Graded on the modified Davis scale · retinal fundus photograph · camera: NIDEK AFC-230 · 848x848:
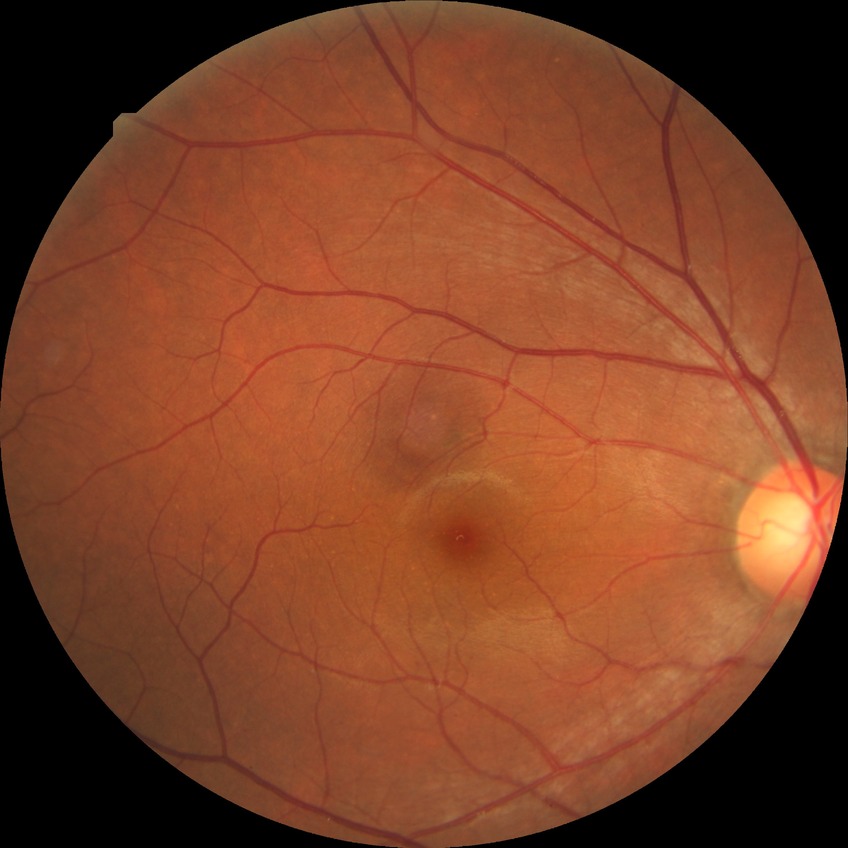

Davis grade: NDR.